45° FOV. Color fundus photograph. 2048 by 1536 pixels.
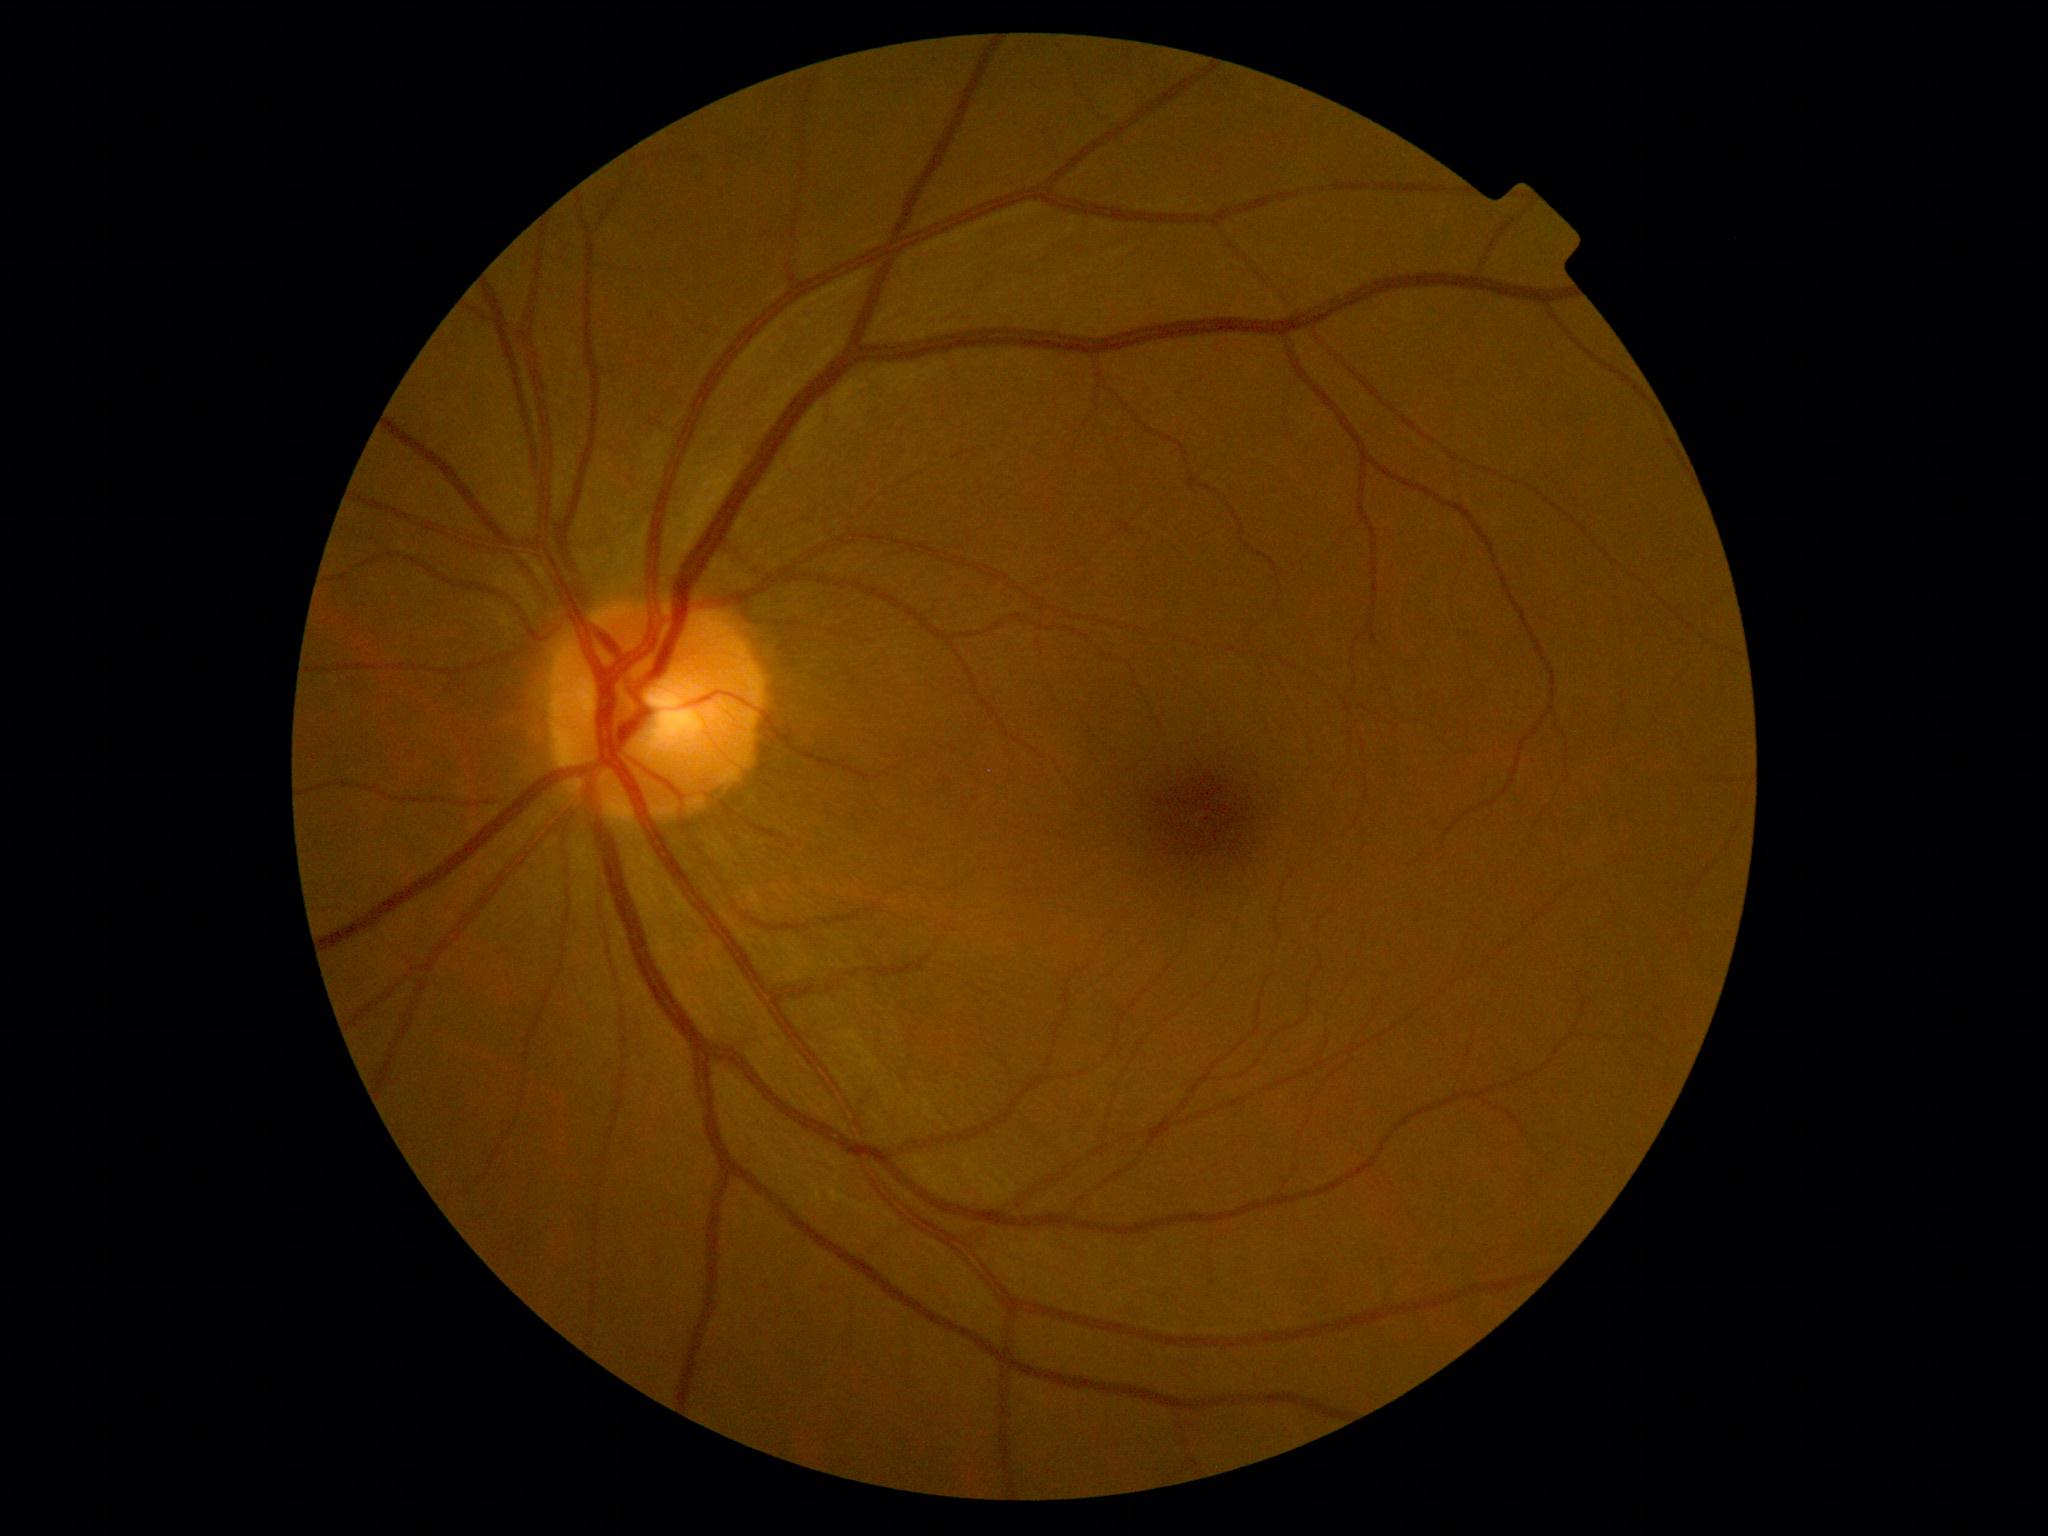
DR stage: 0.
No DR findings.